Color fundus image; 45 degree fundus photograph; nonmydriatic fundus photograph; graded on the modified Davis scale:
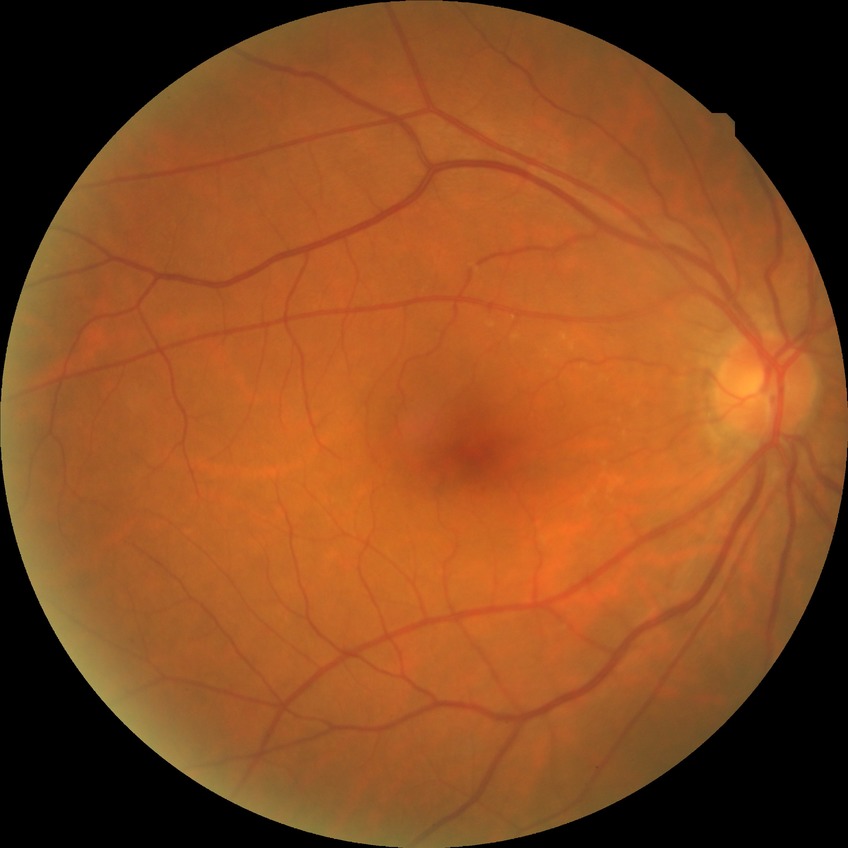

DR class: non-proliferative diabetic retinopathy; diabetic retinopathy (DR): simple diabetic retinopathy (SDR).